Camera: Remidio Fundus on Phone; retinal fundus photograph — 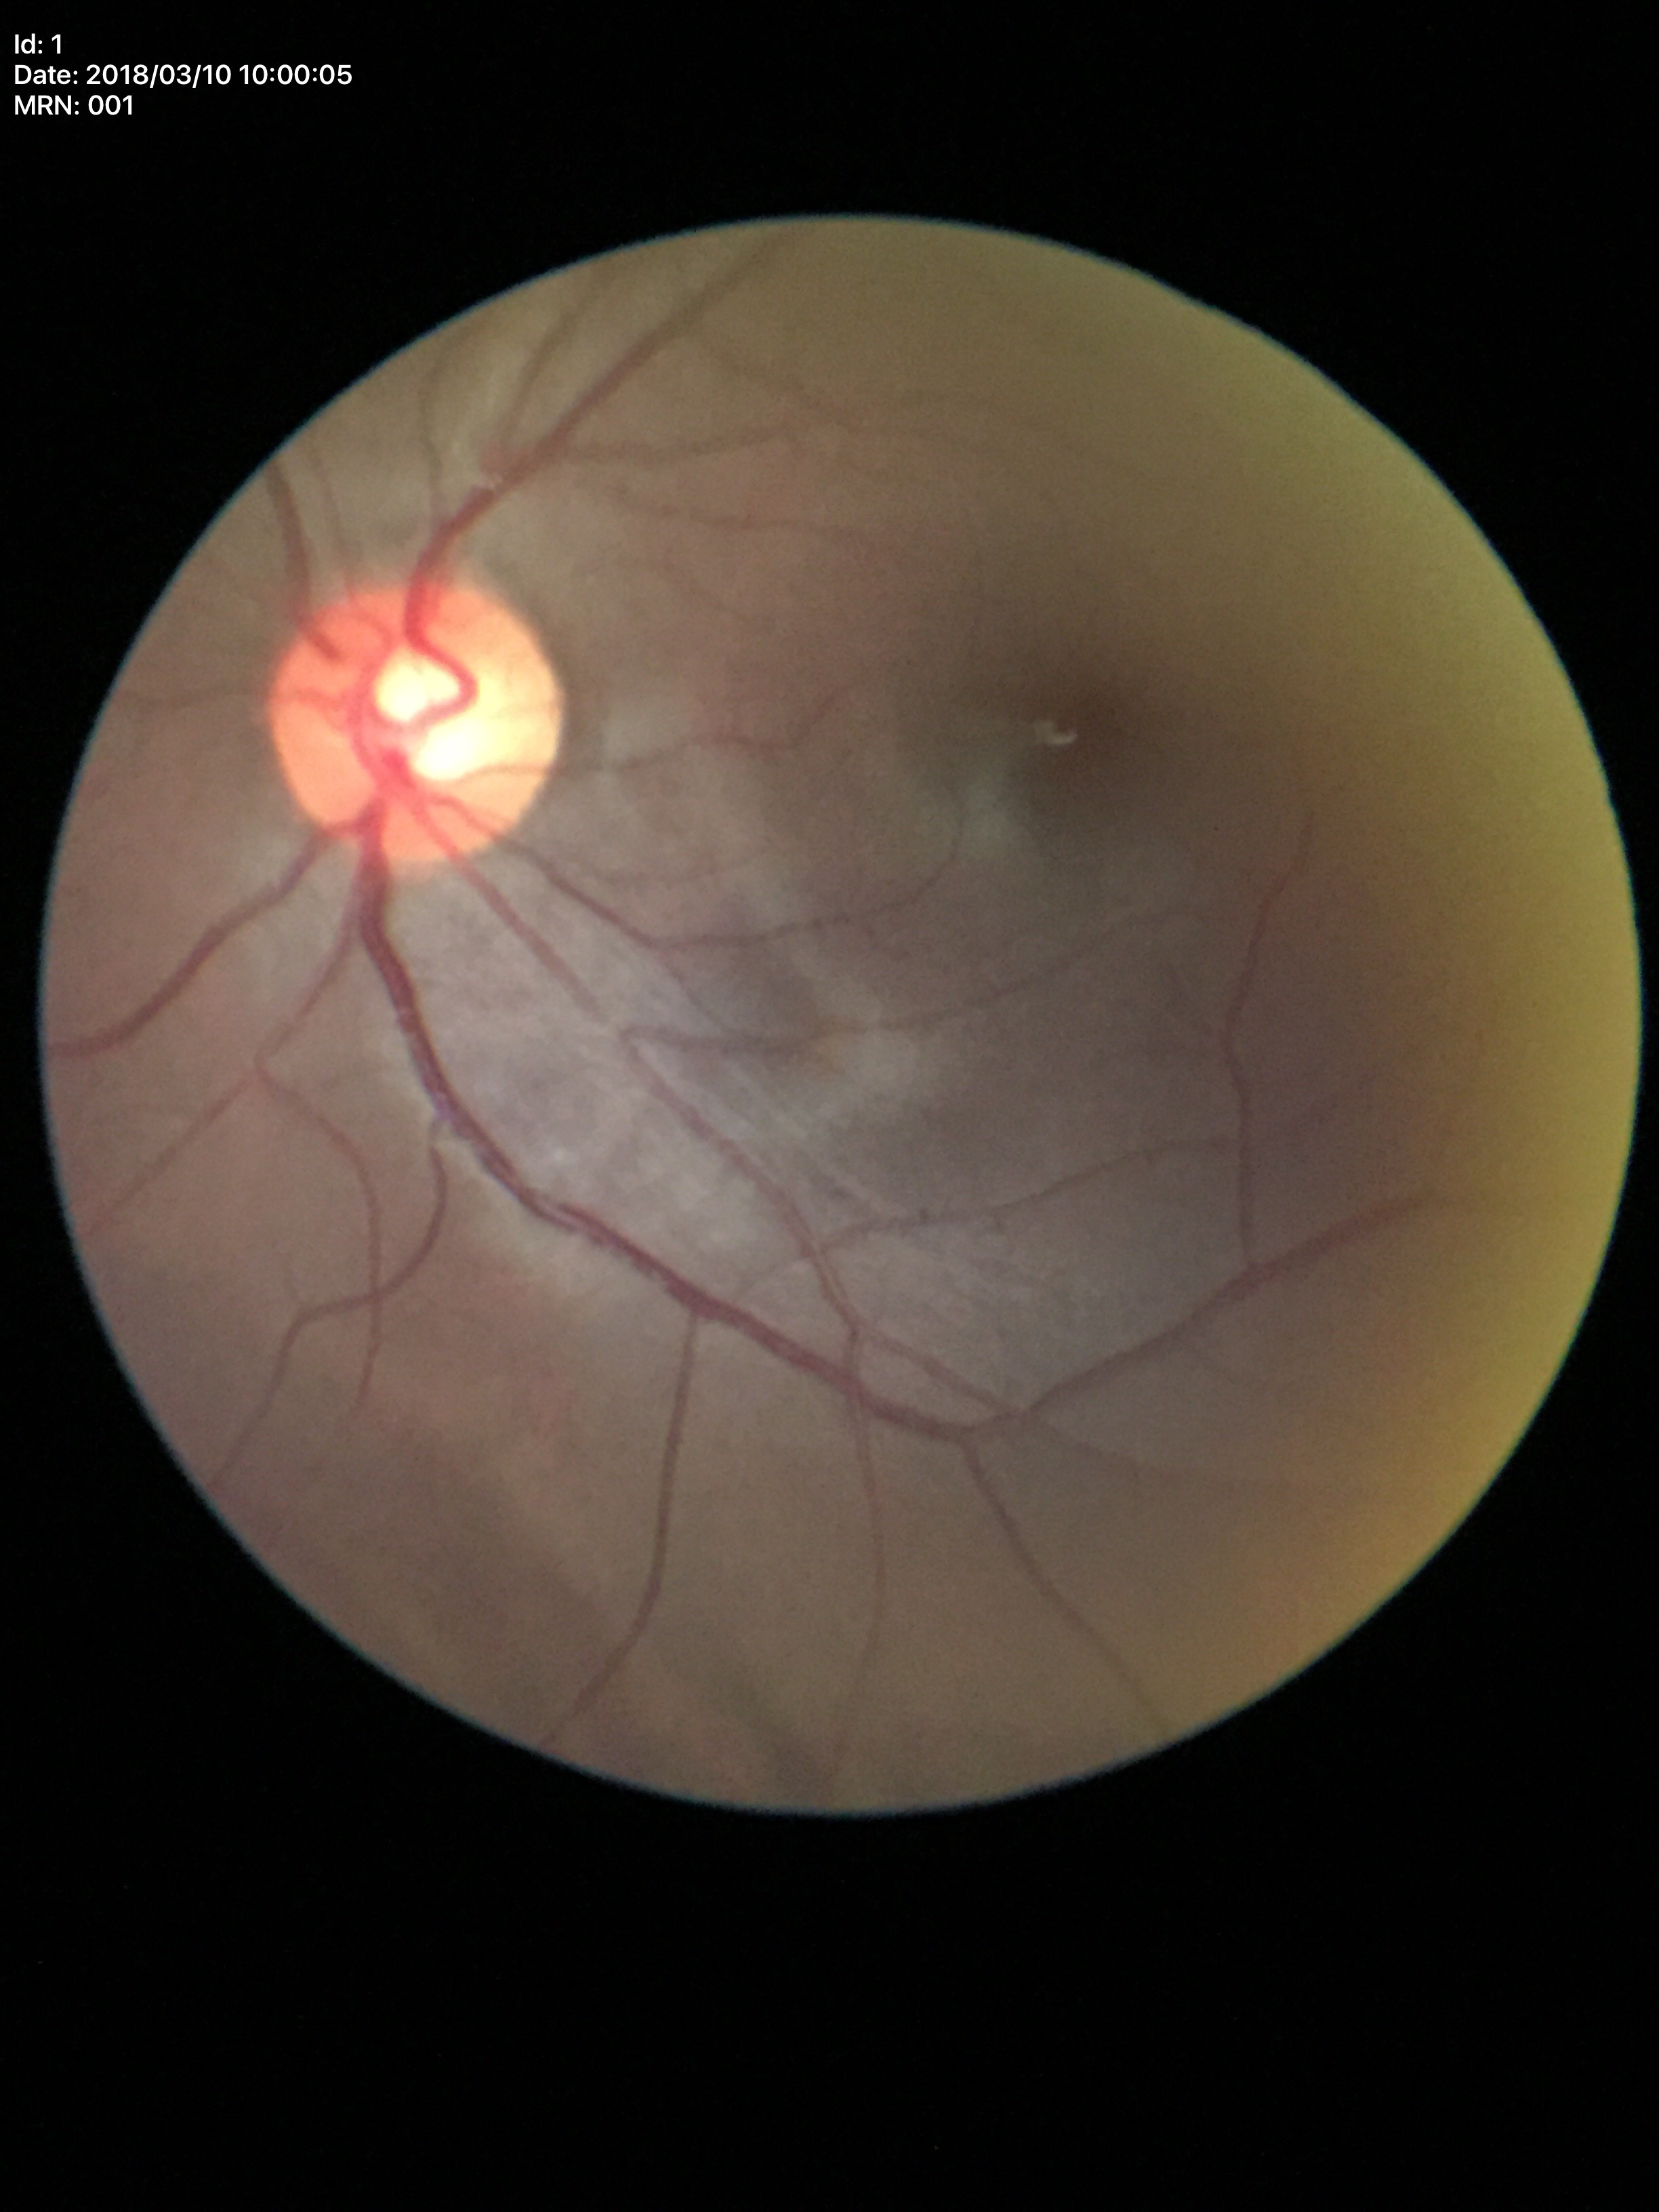
Q: Glaucoma screening result?
A: negative
Q: Vertical CDR?
A: 0.54
Q: What is the HCDR?
A: 0.54
Q: What is the ACDR?
A: 0.29